Color fundus photograph · 2352 by 1568 pixels — 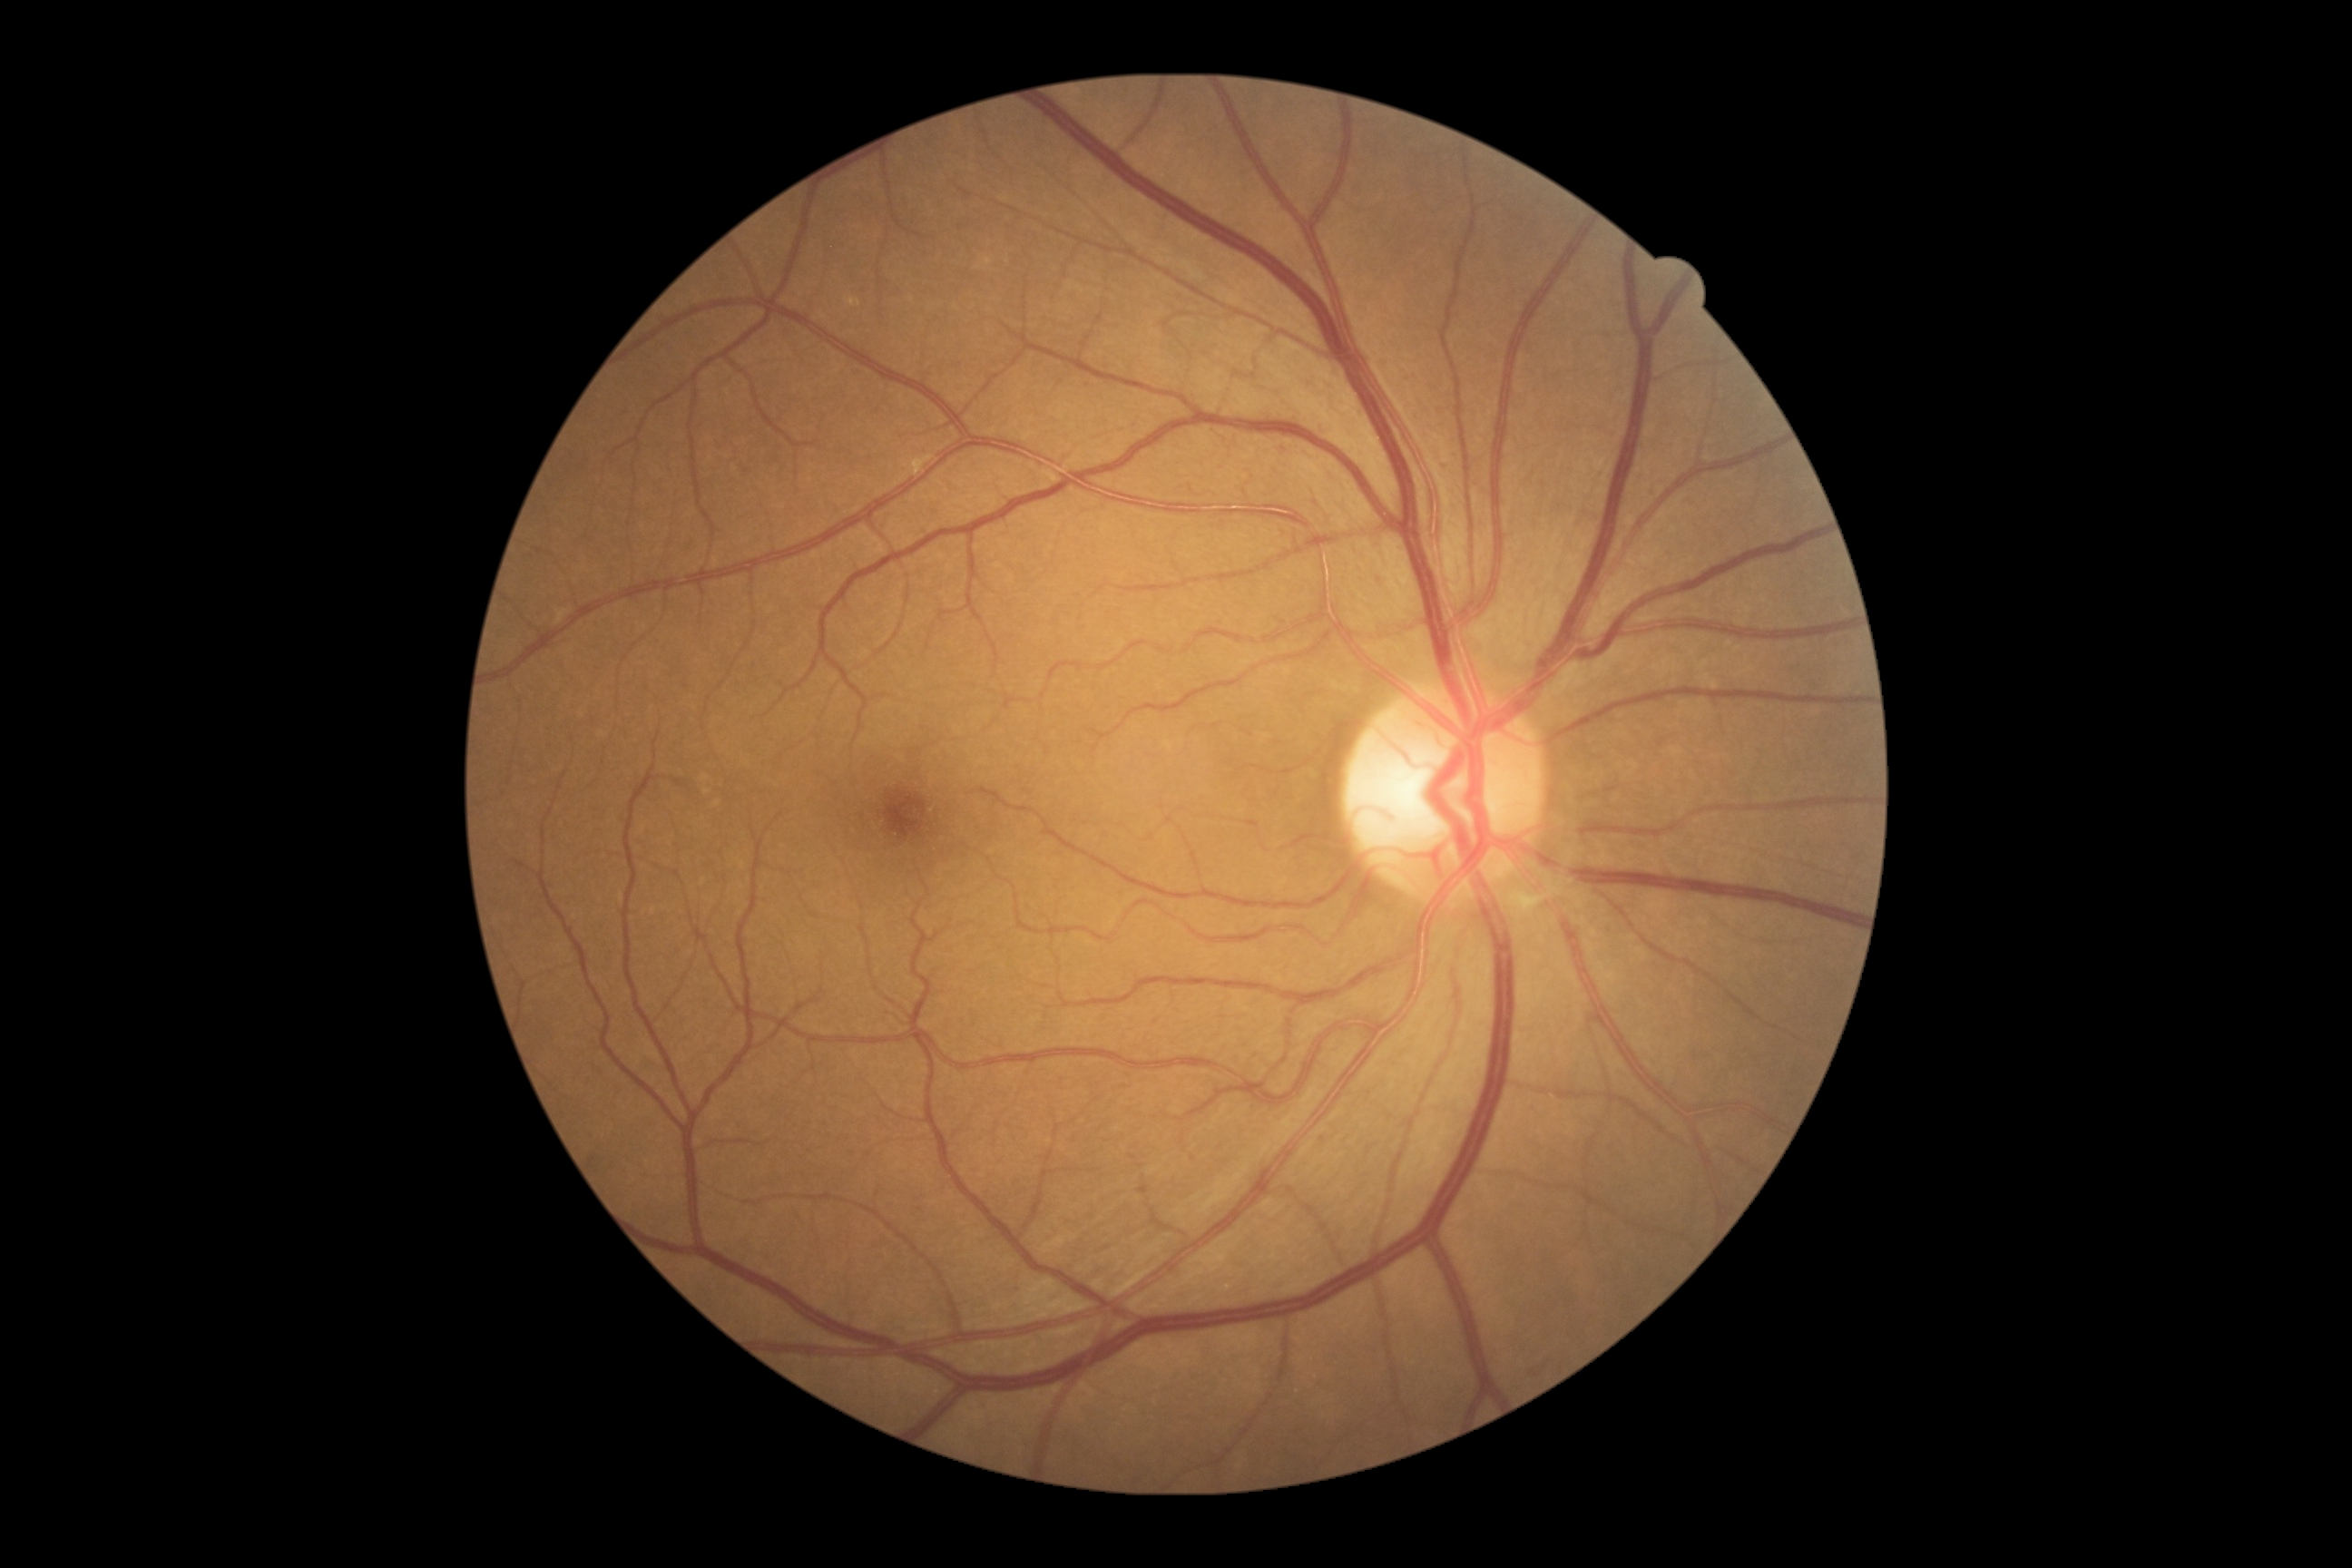 DR is 0.